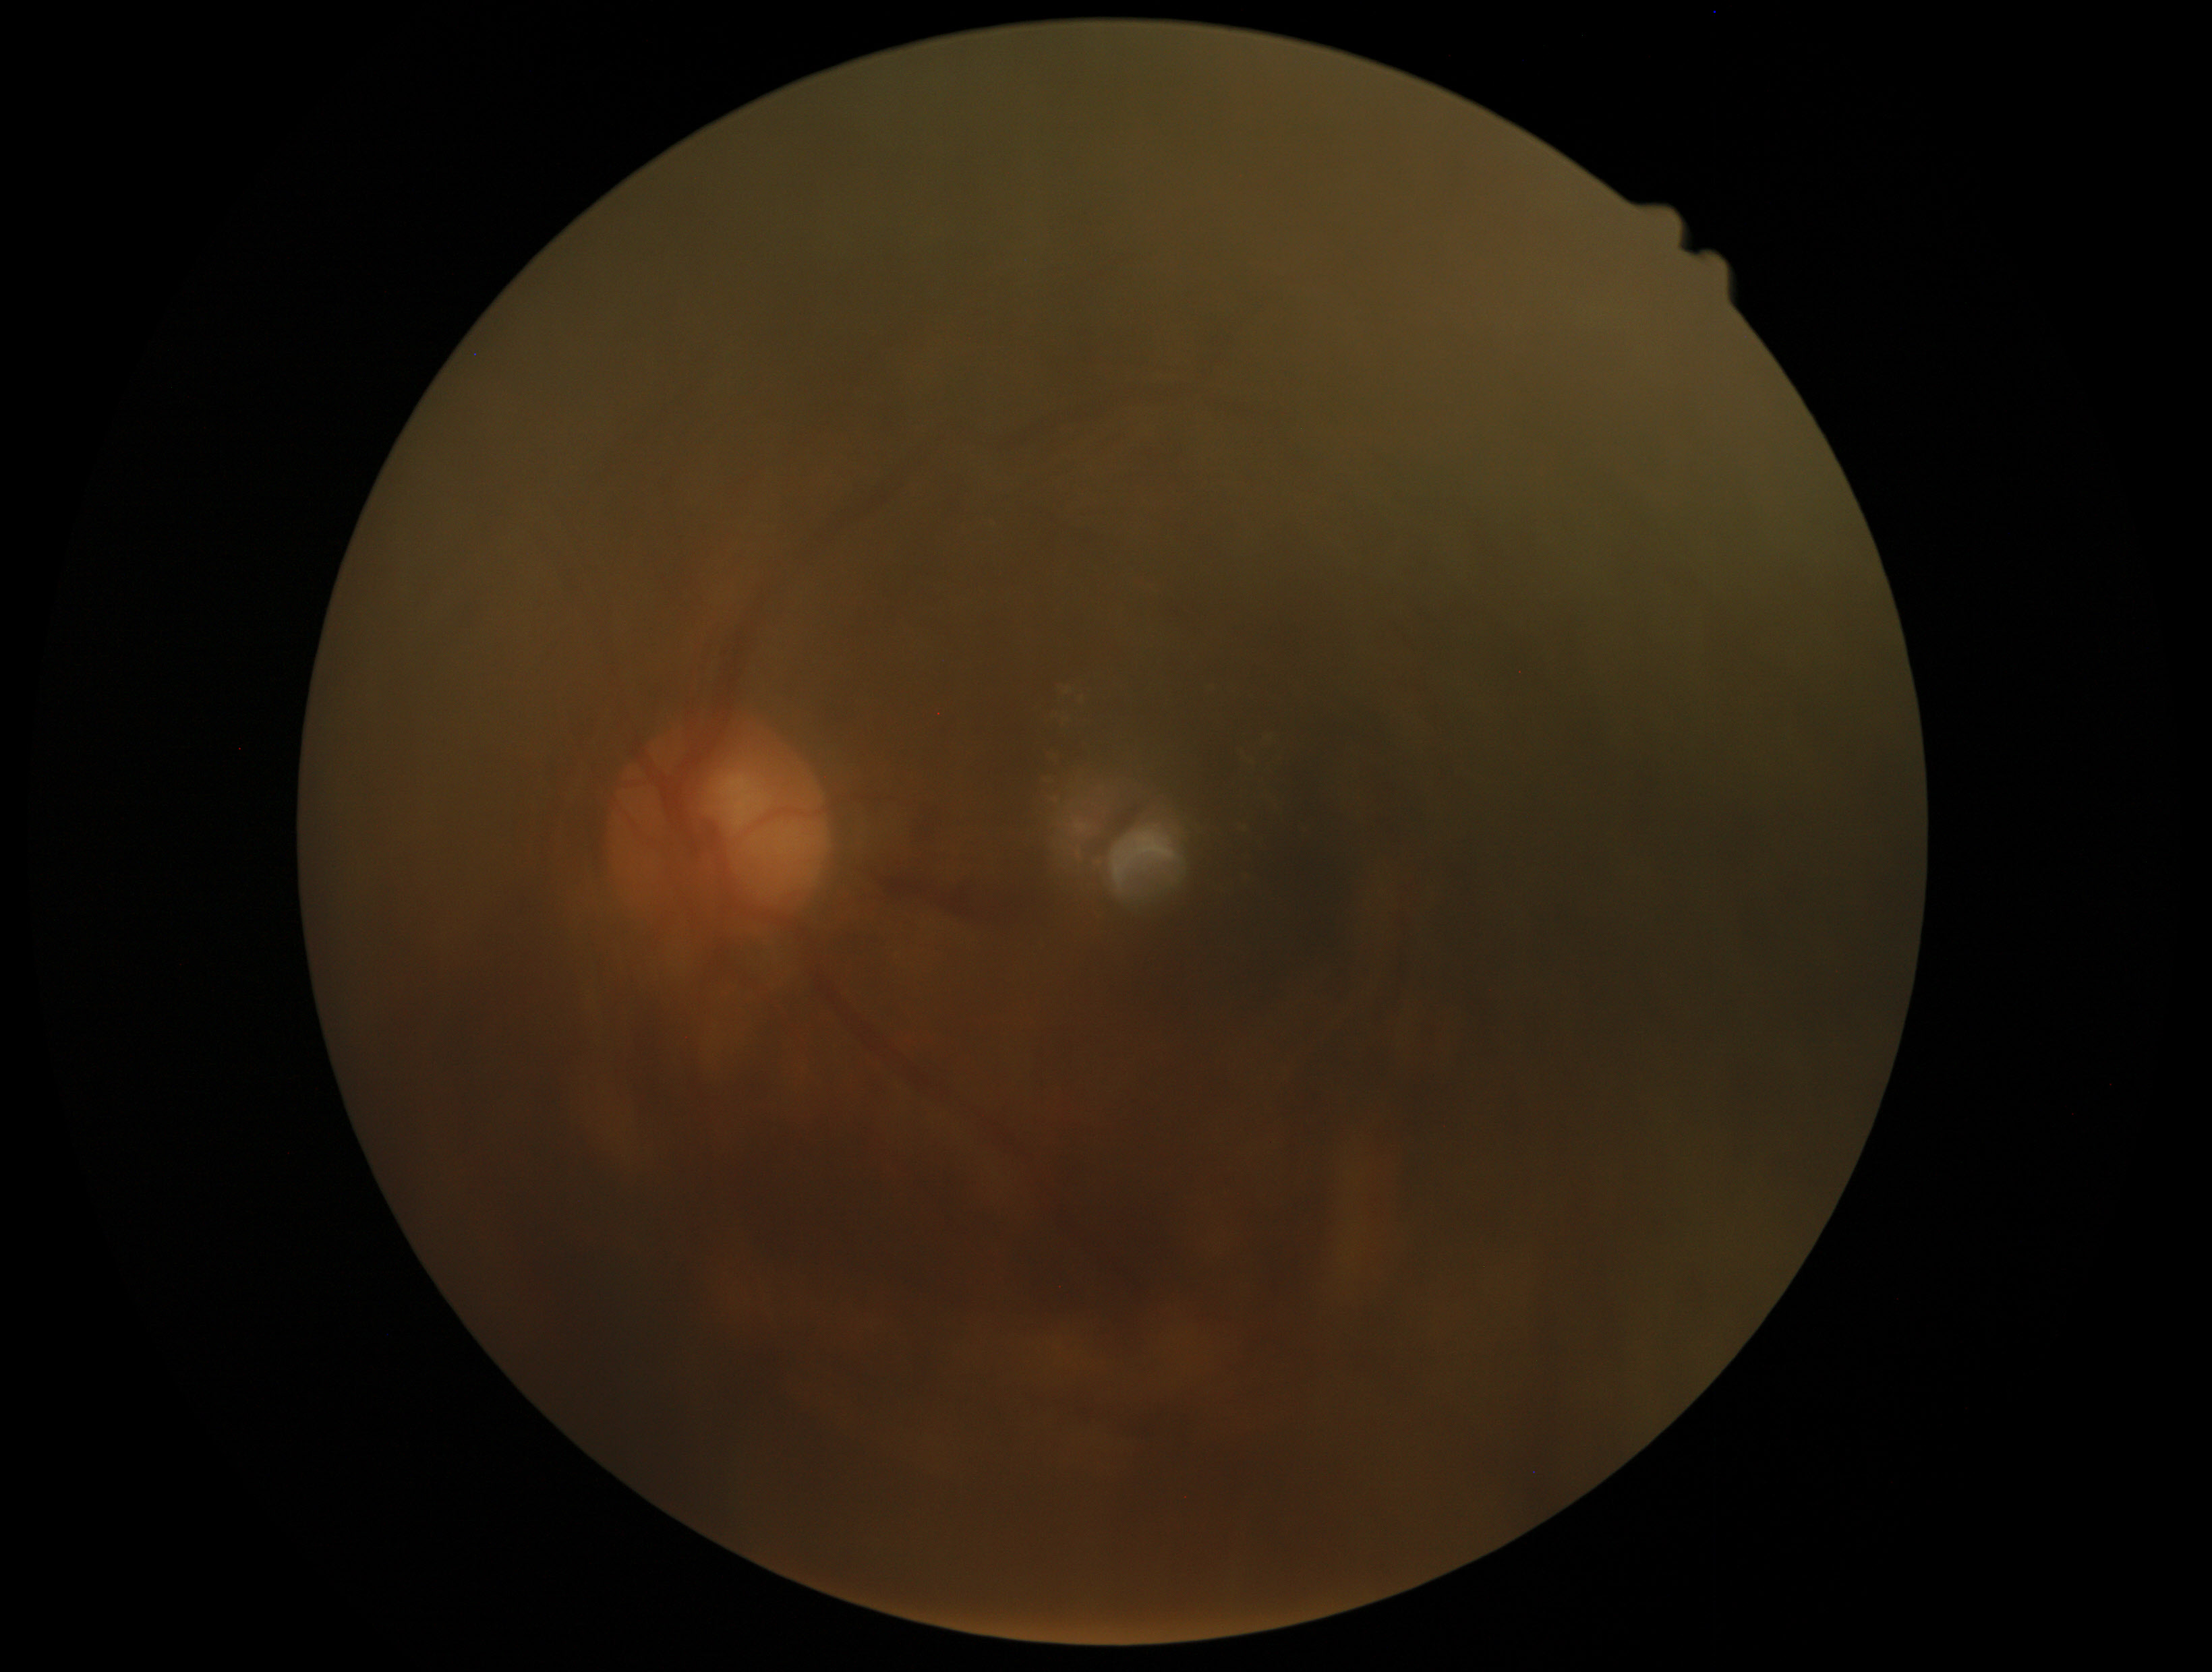 DR grade is 2 (moderate NPDR). DR class: non-proliferative diabetic retinopathy.